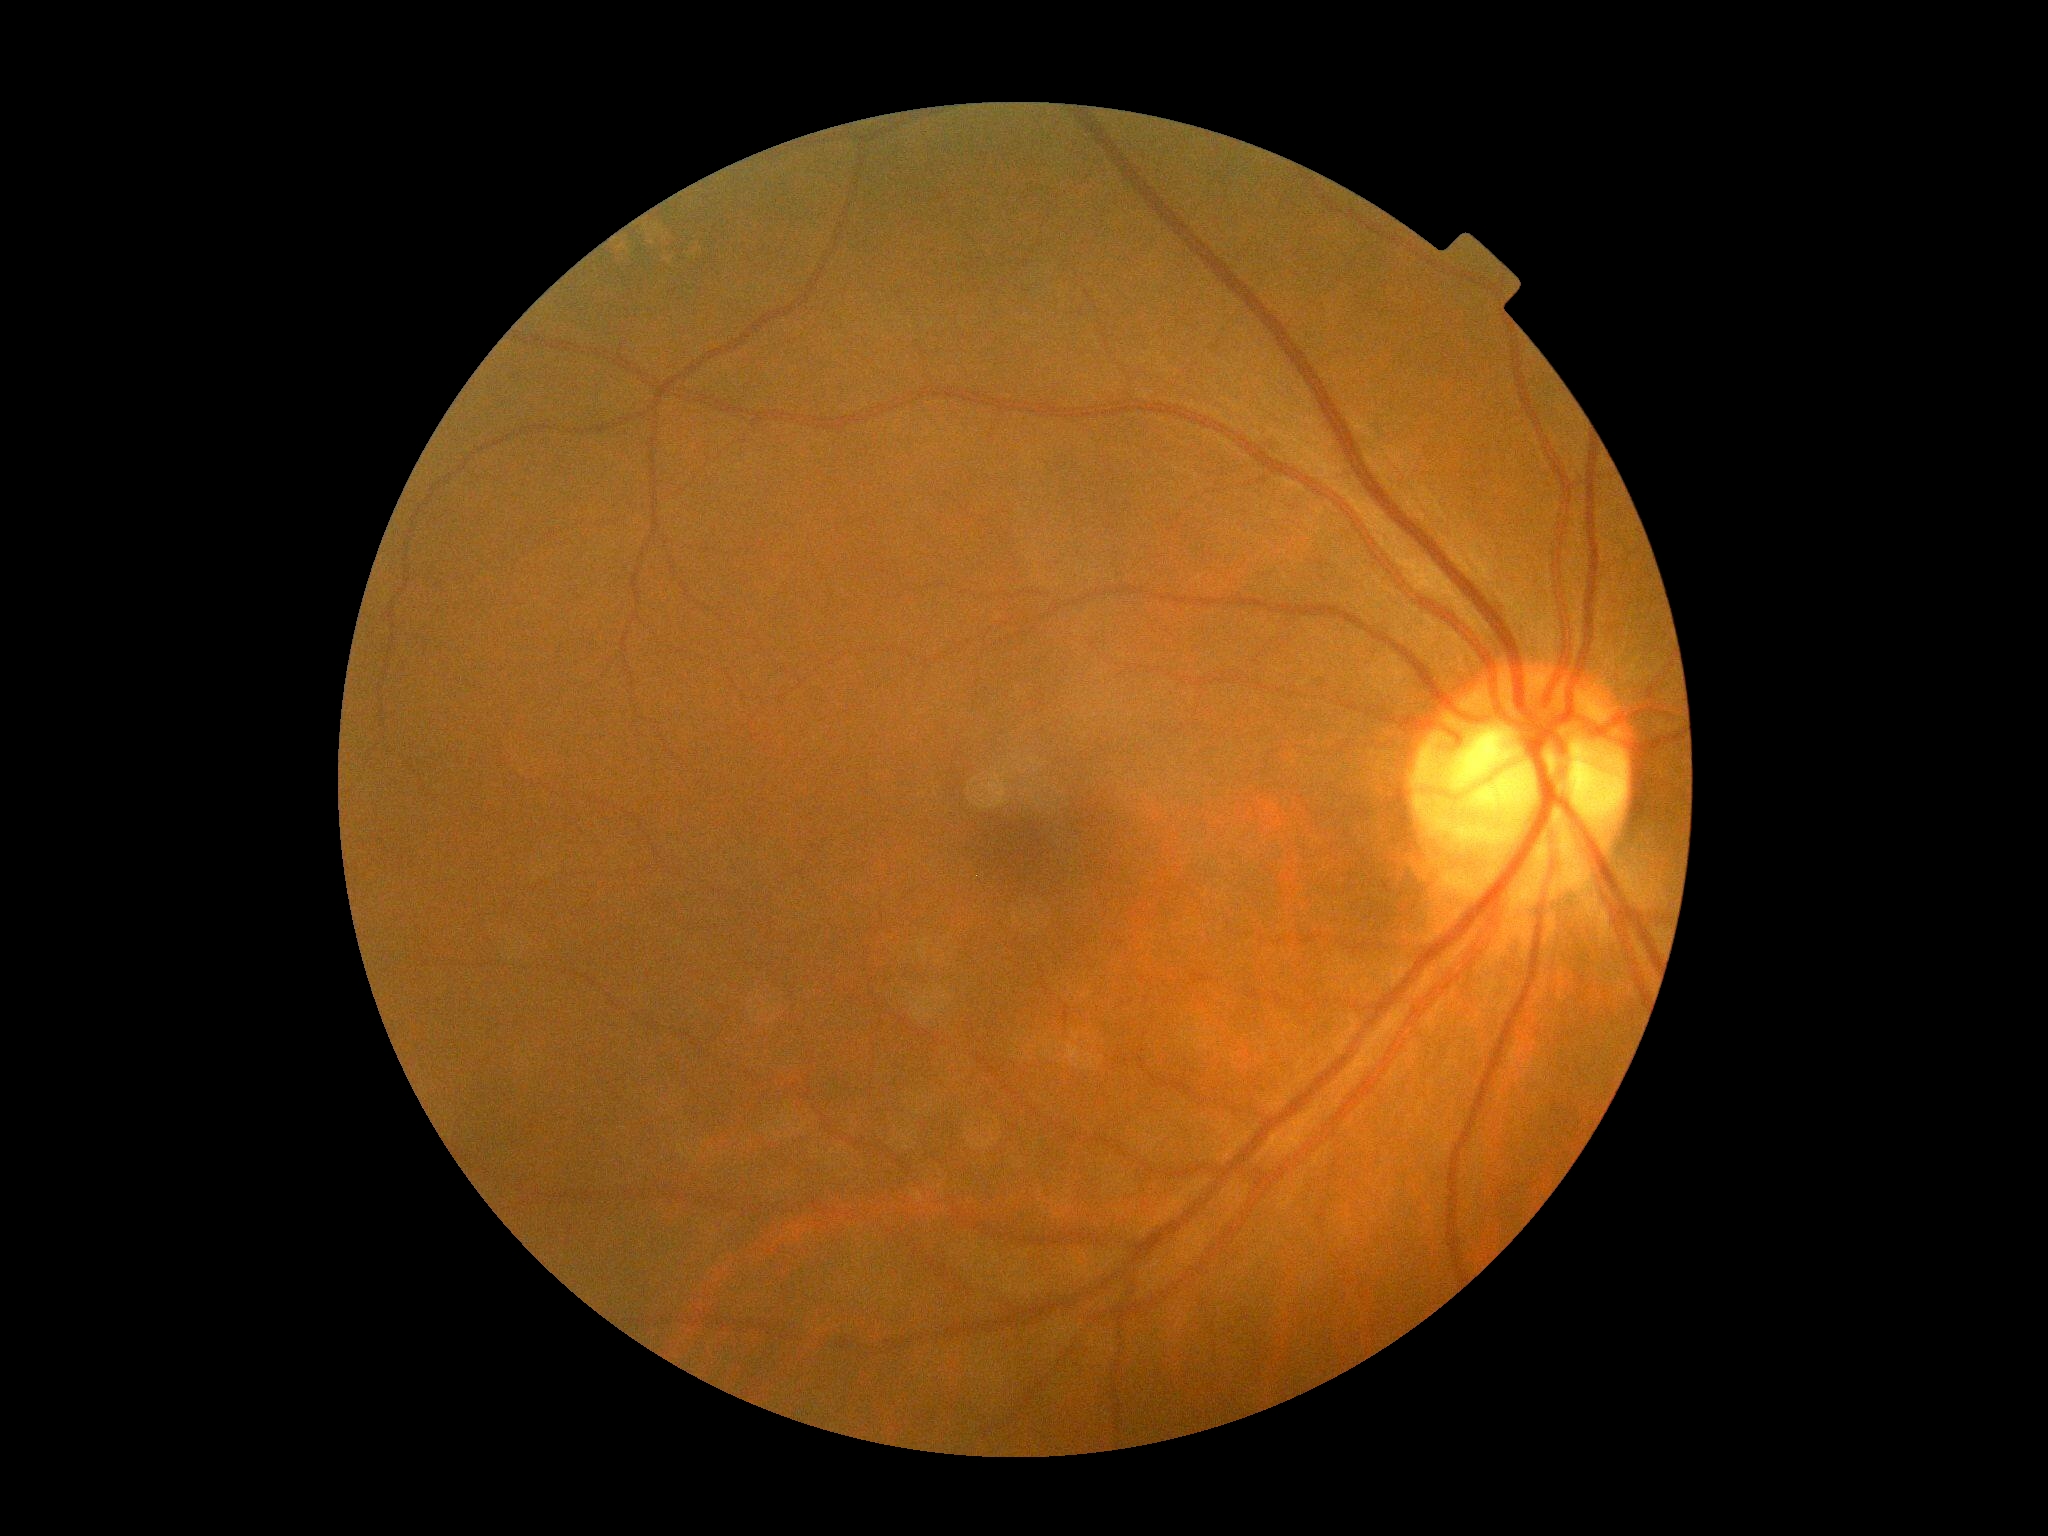

DR is no apparent diabetic retinopathy (grade 0).
No DR findings.